848 by 848 pixels.
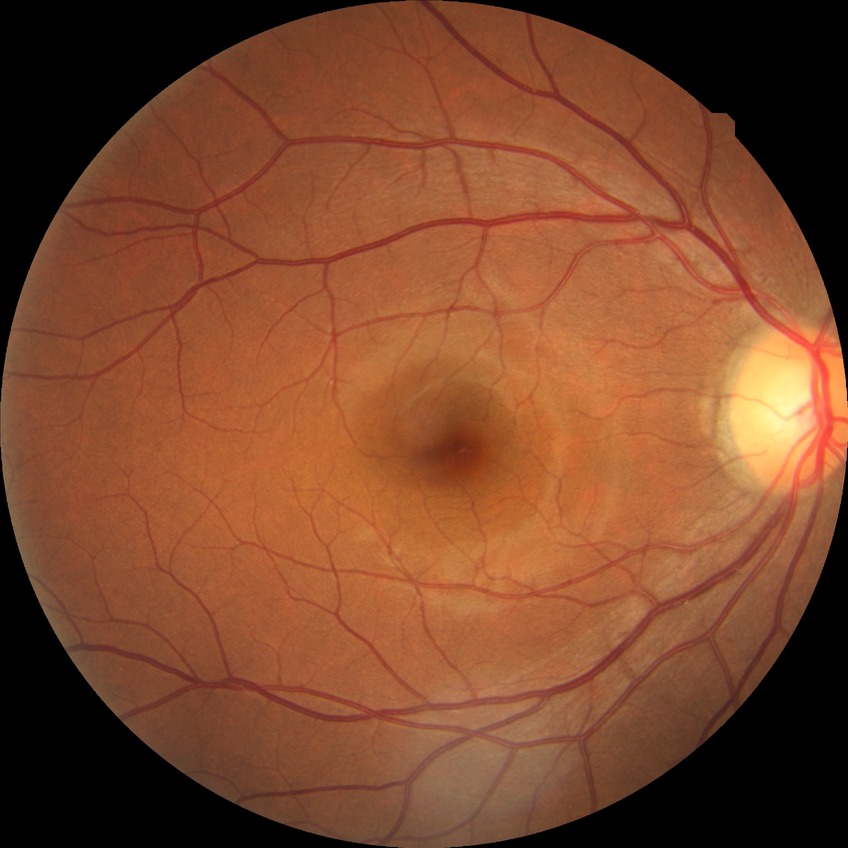 - retinopathy grade: no diabetic retinopathy